CFP, 2352x1568, 45° field of view:
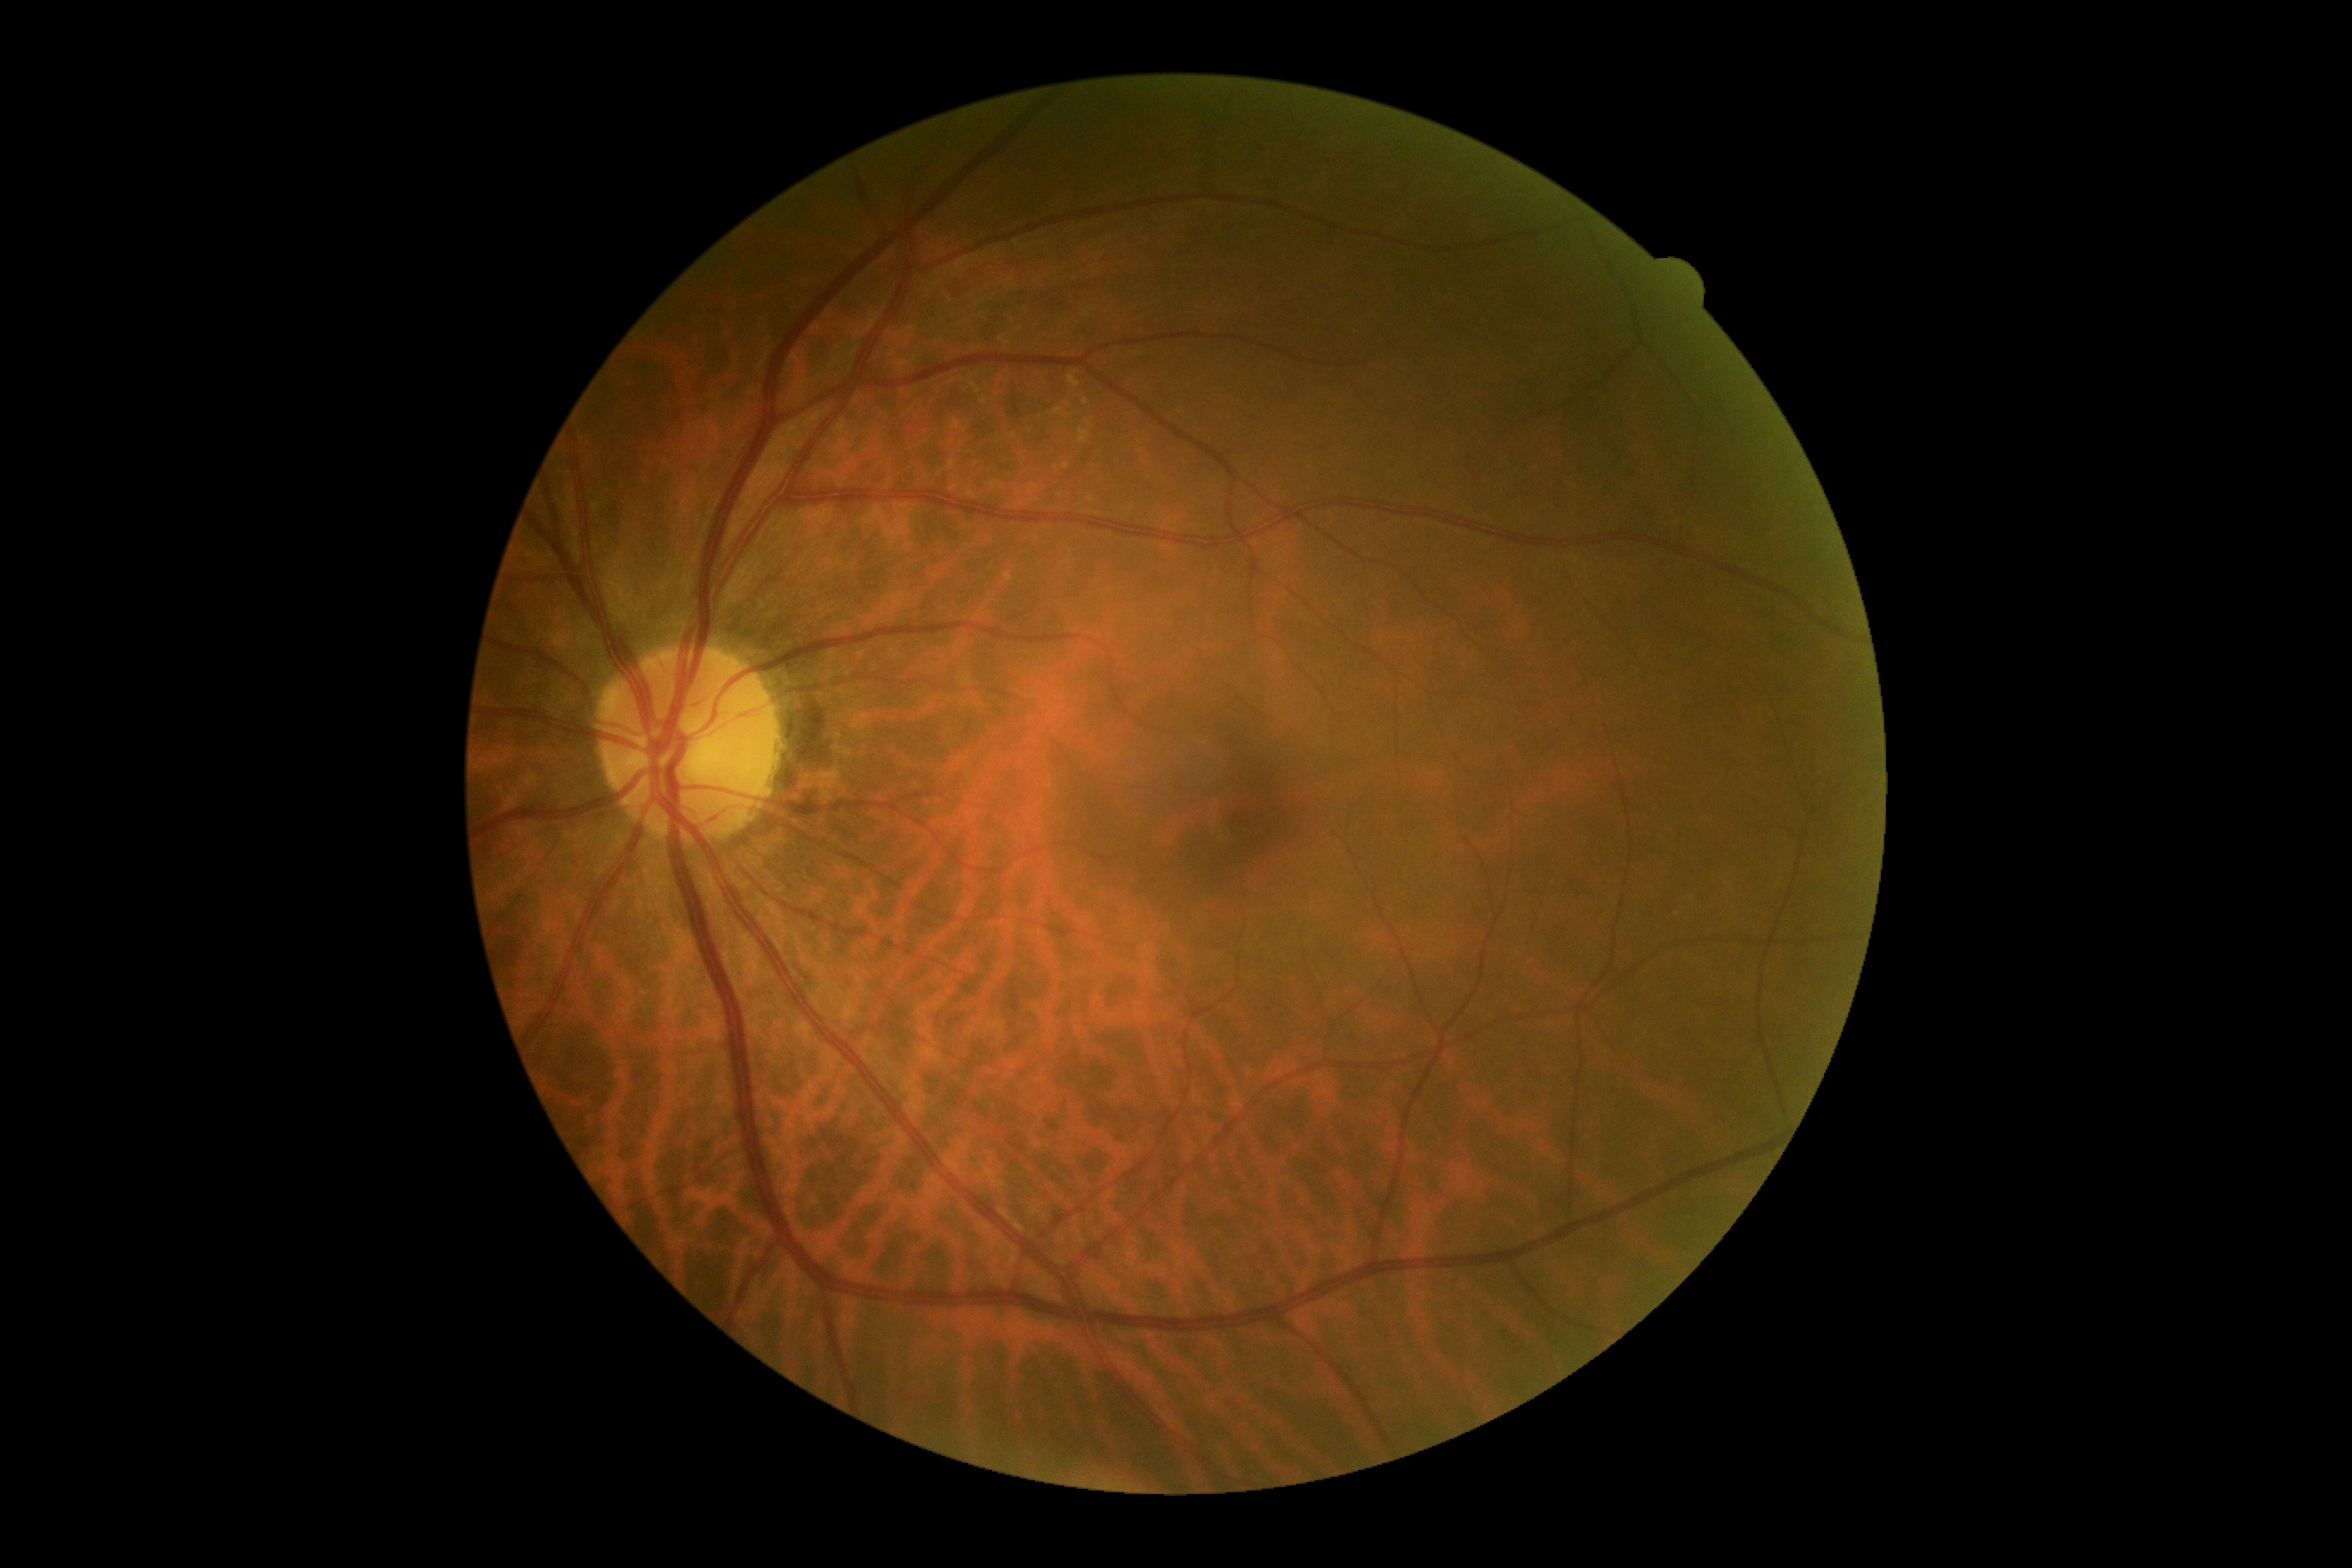

diabetic retinopathy: grade 0 (no apparent retinopathy)